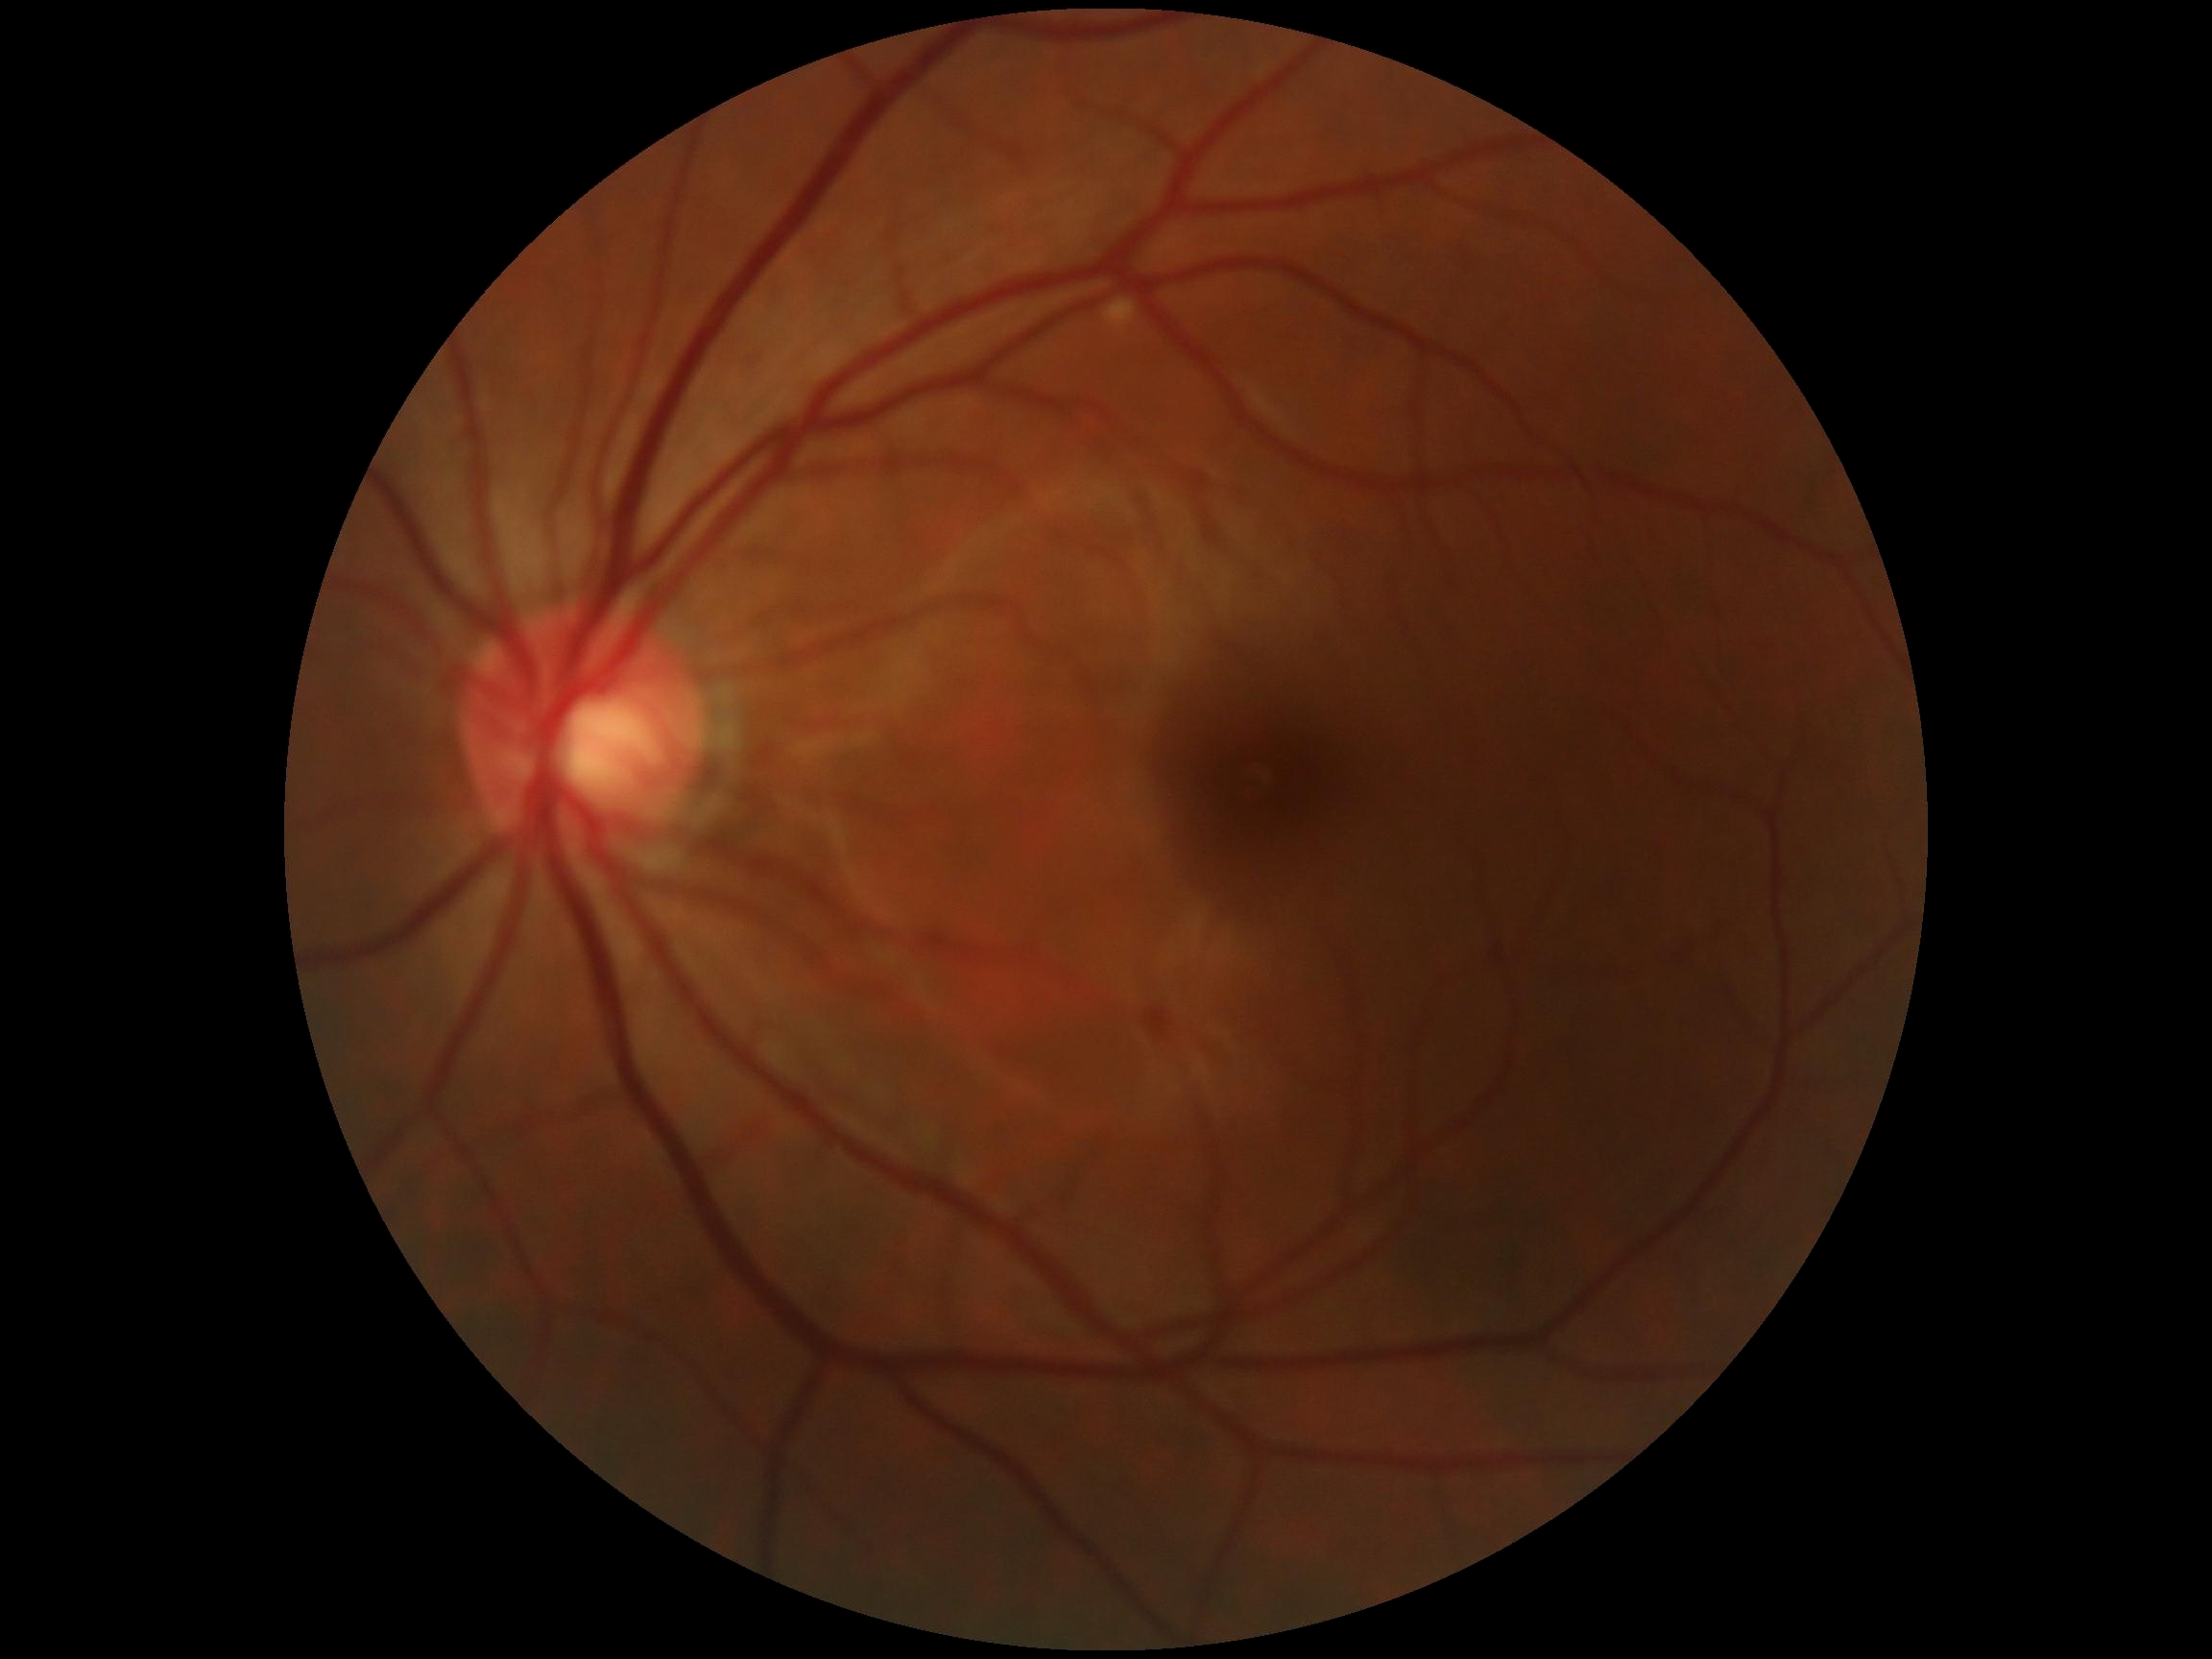

{
  "dr_grade": "0/4"
}